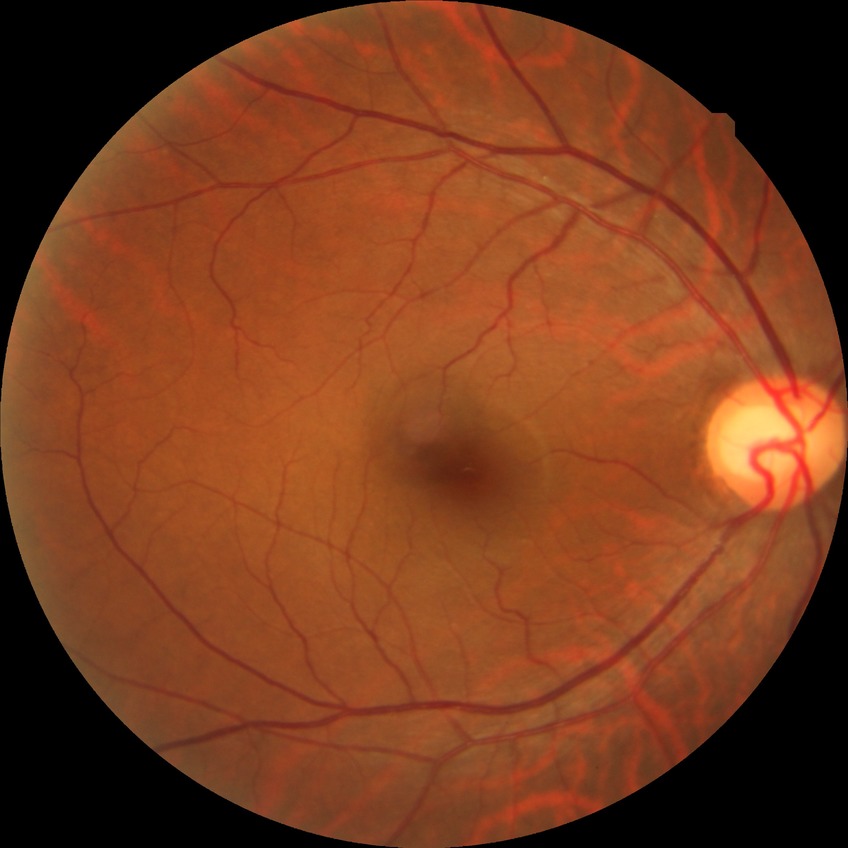
Davis stage: NDR. No diabetic retinal disease findings.